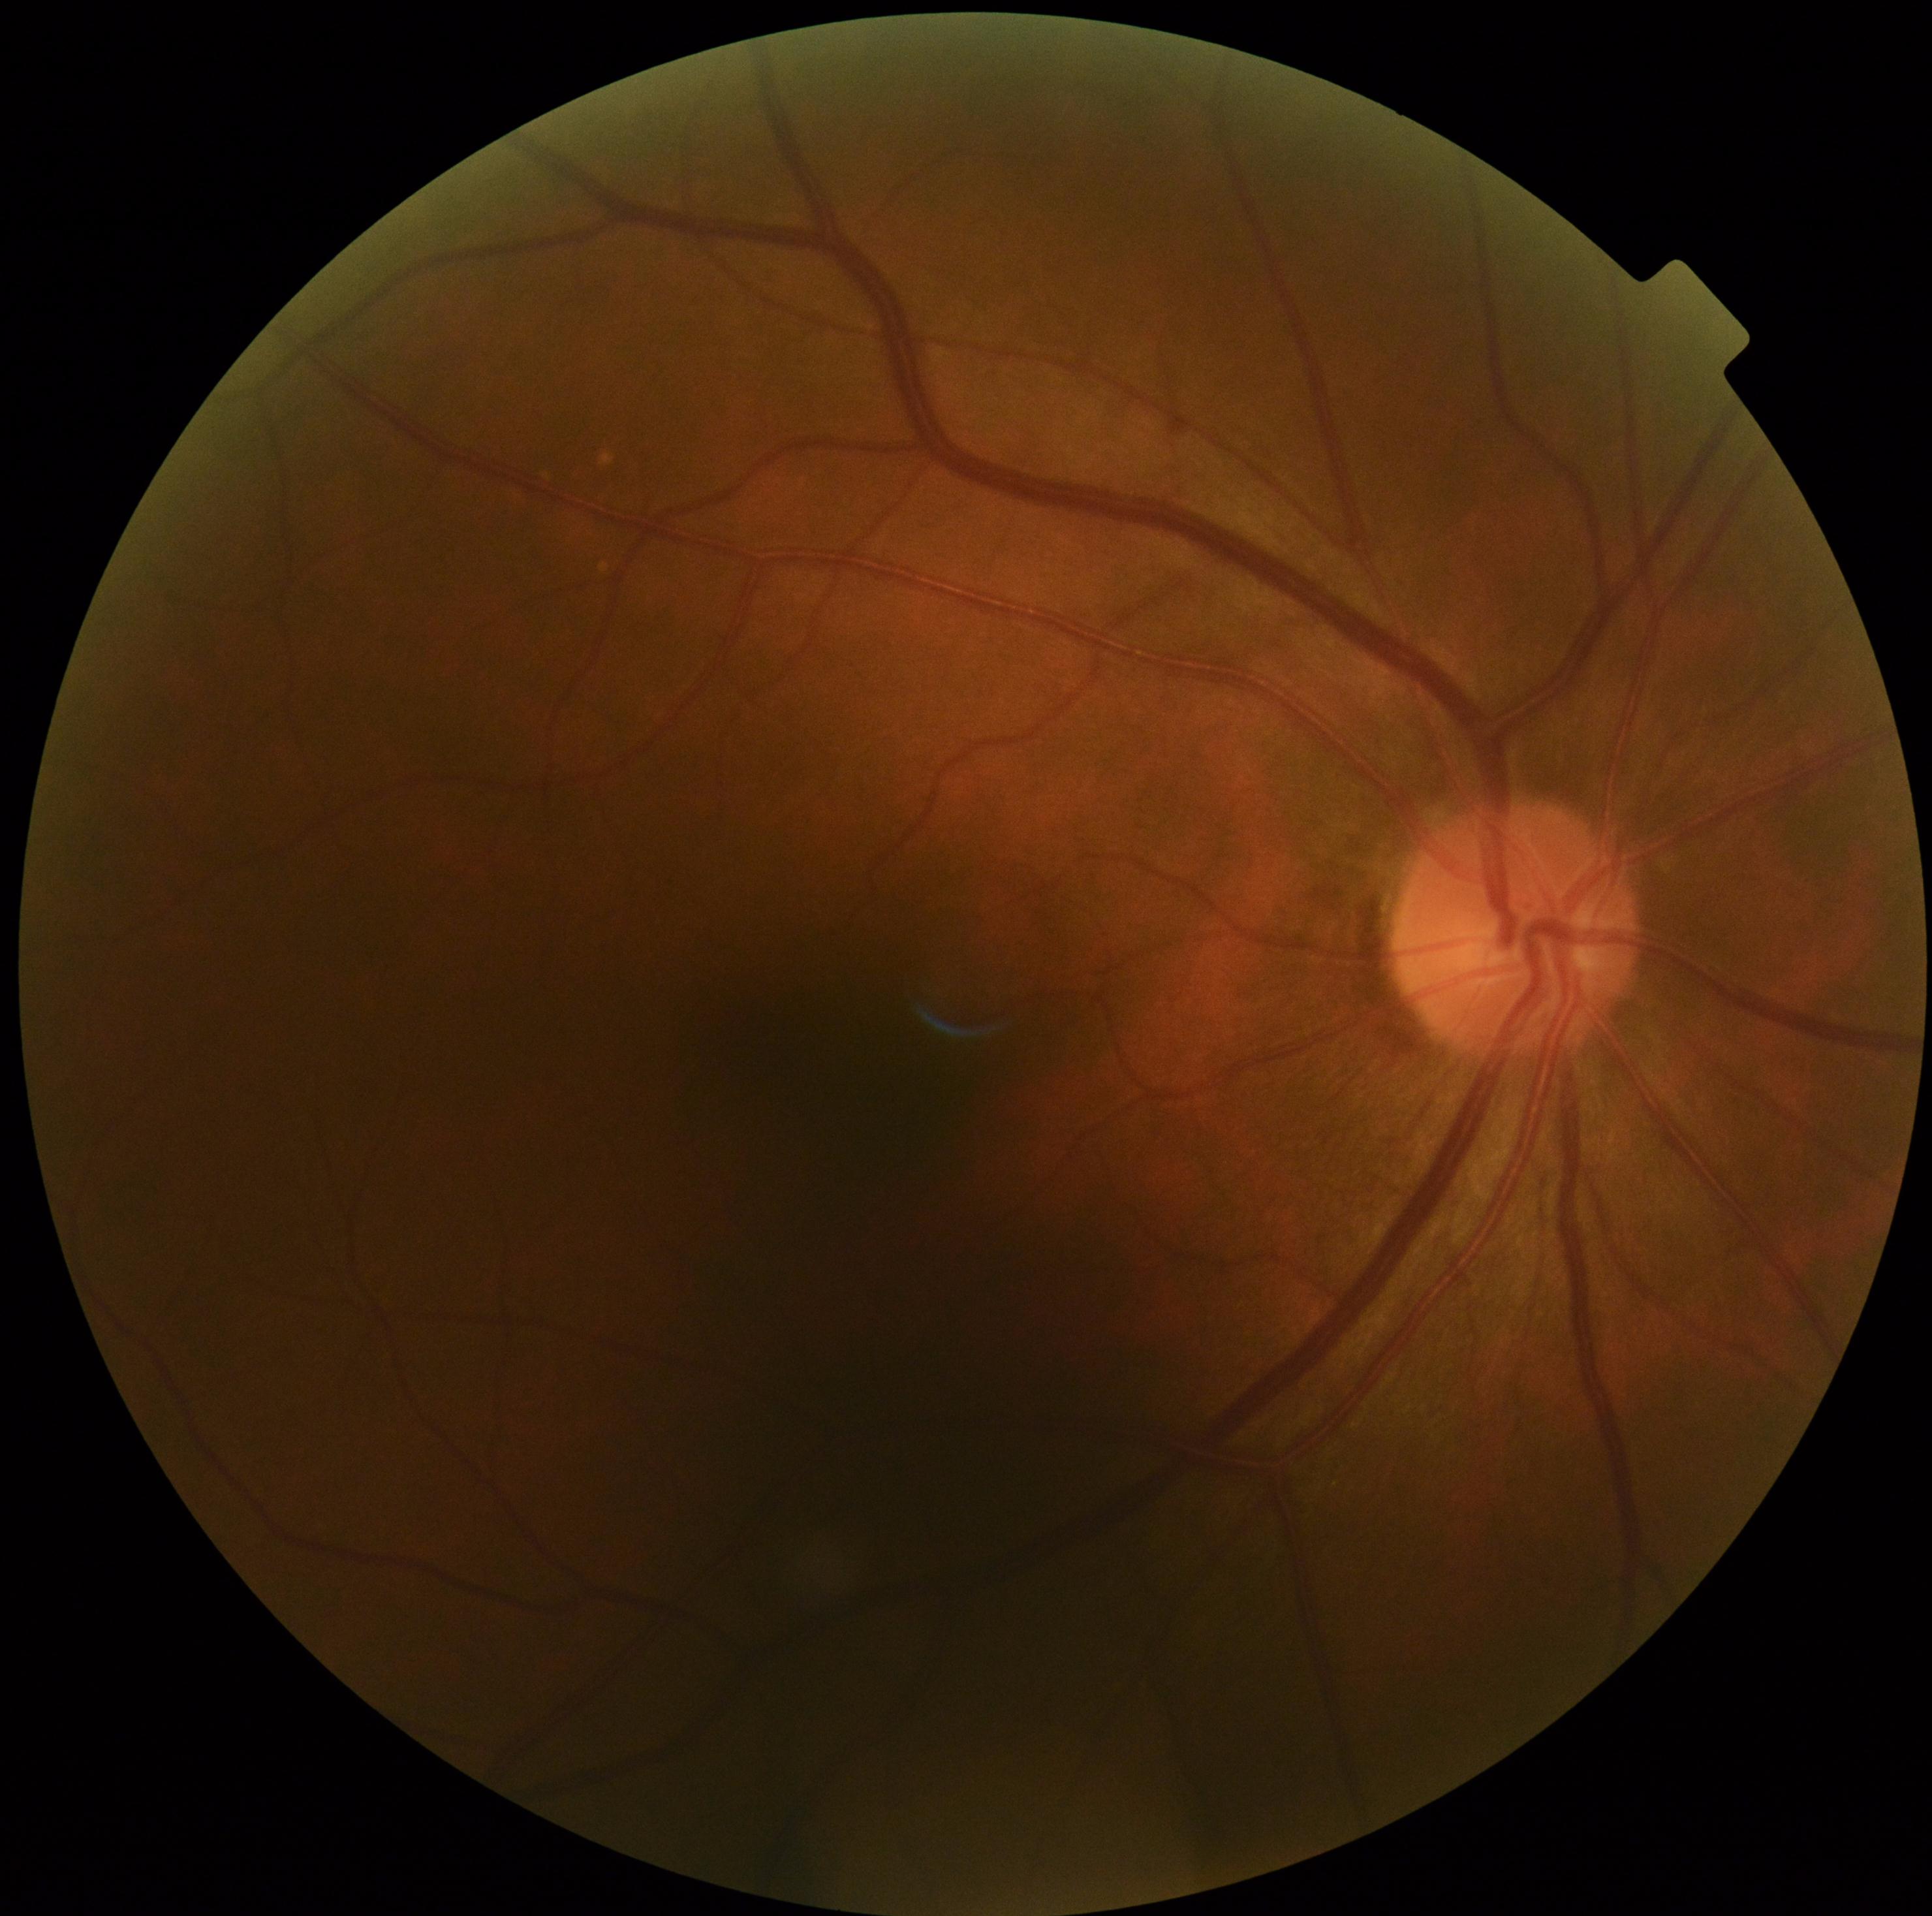 Diabetic retinopathy (DR) is no apparent retinopathy (grade 0) — no visible signs of diabetic retinopathy.